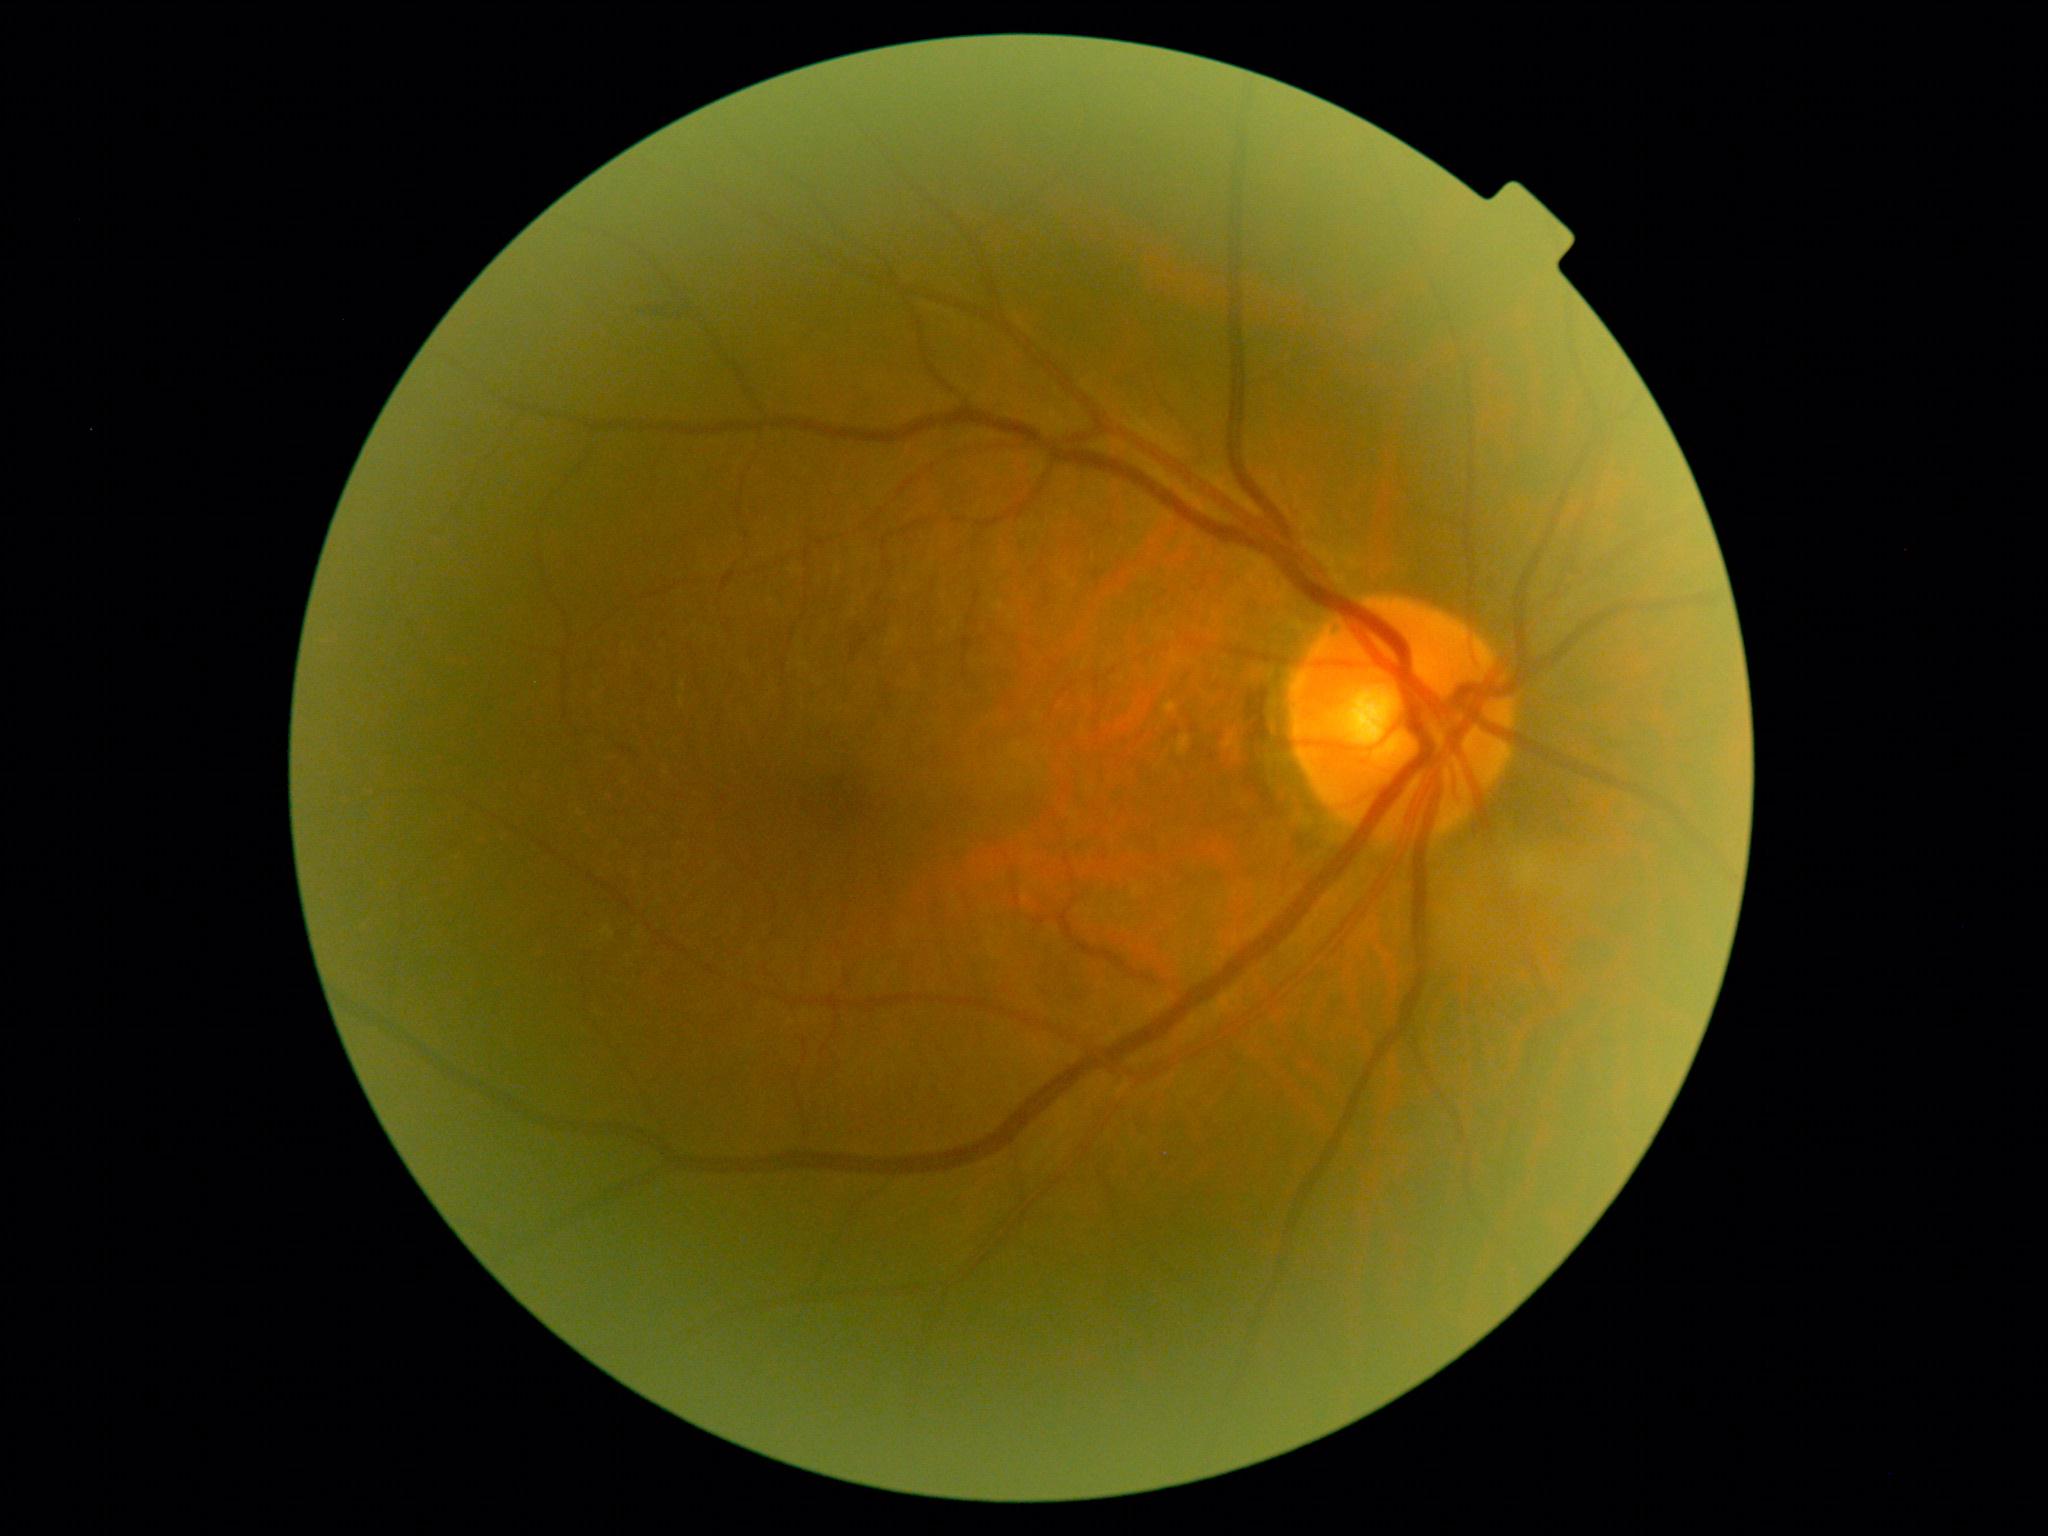

- diabetic retinopathy (DR) — grade 2